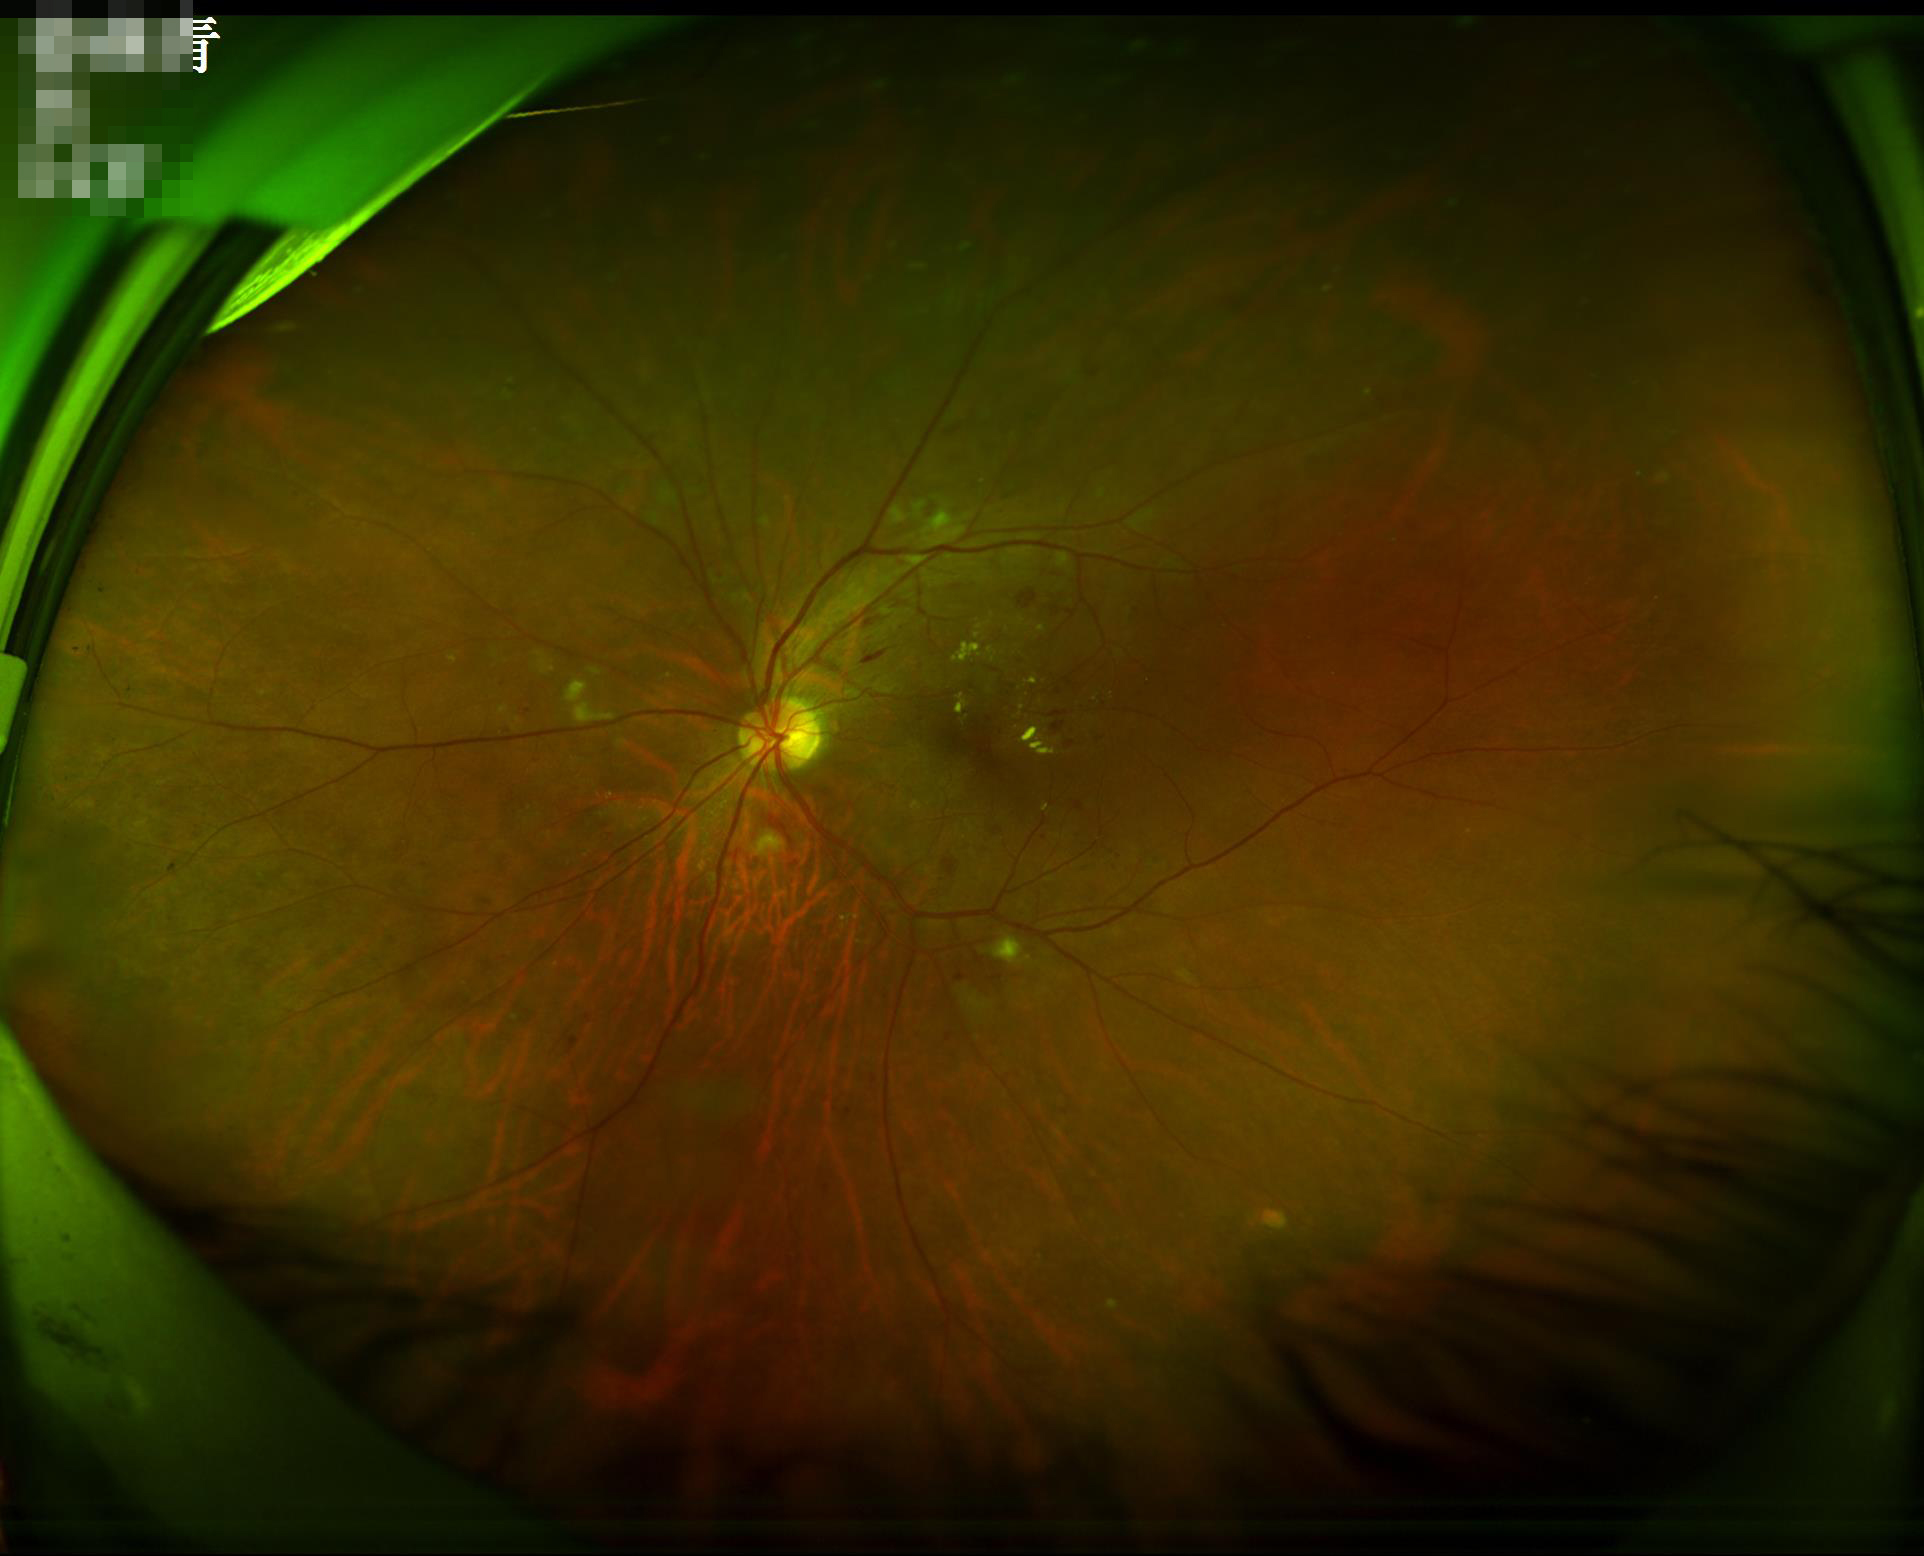 Illumination/color: satisfactory
Overall quality: adequate